Posterior pole photograph.
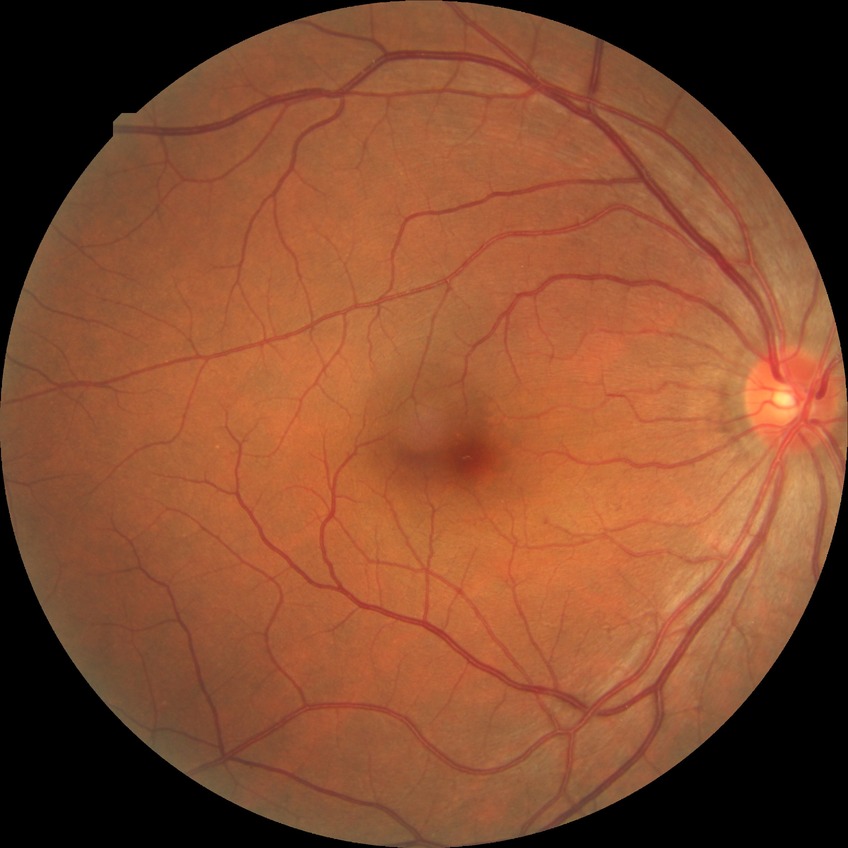
Diabetic retinopathy stage is no diabetic retinopathy.